Infant wide-field retinal image:
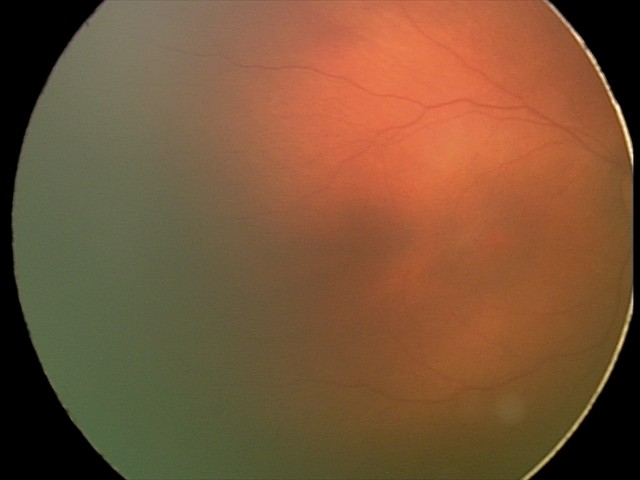
Assessment = physiological appearance.